848x848 · NIDEK AFC-230 fundus camera · 45° field of view · without pupil dilation — 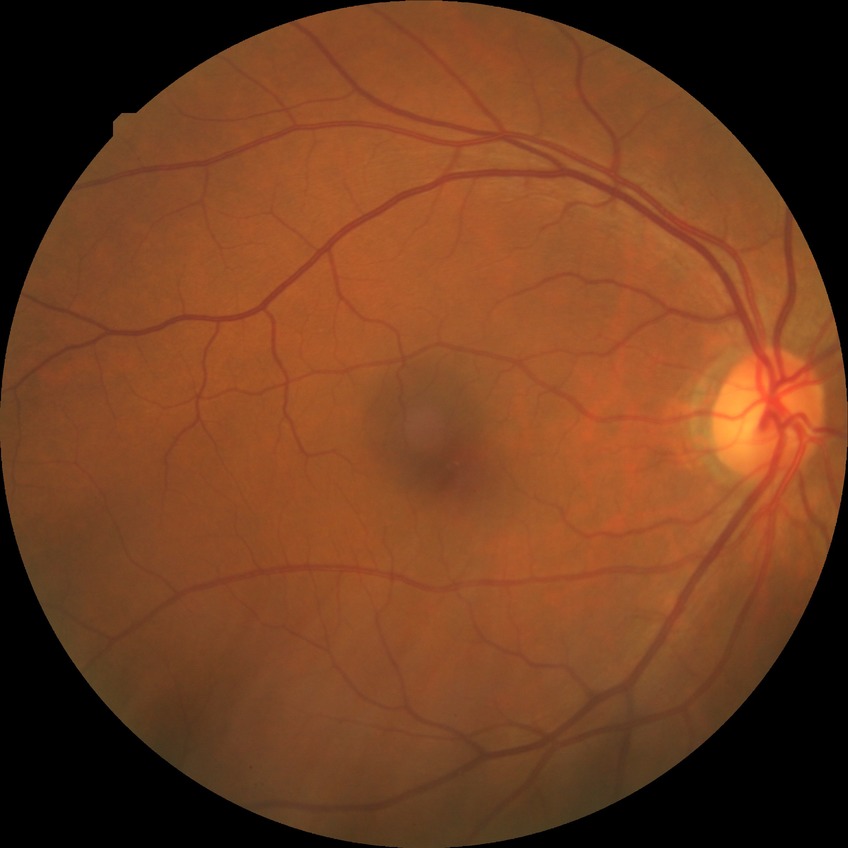
Diabetic retinopathy (DR): no diabetic retinopathy (NDR).